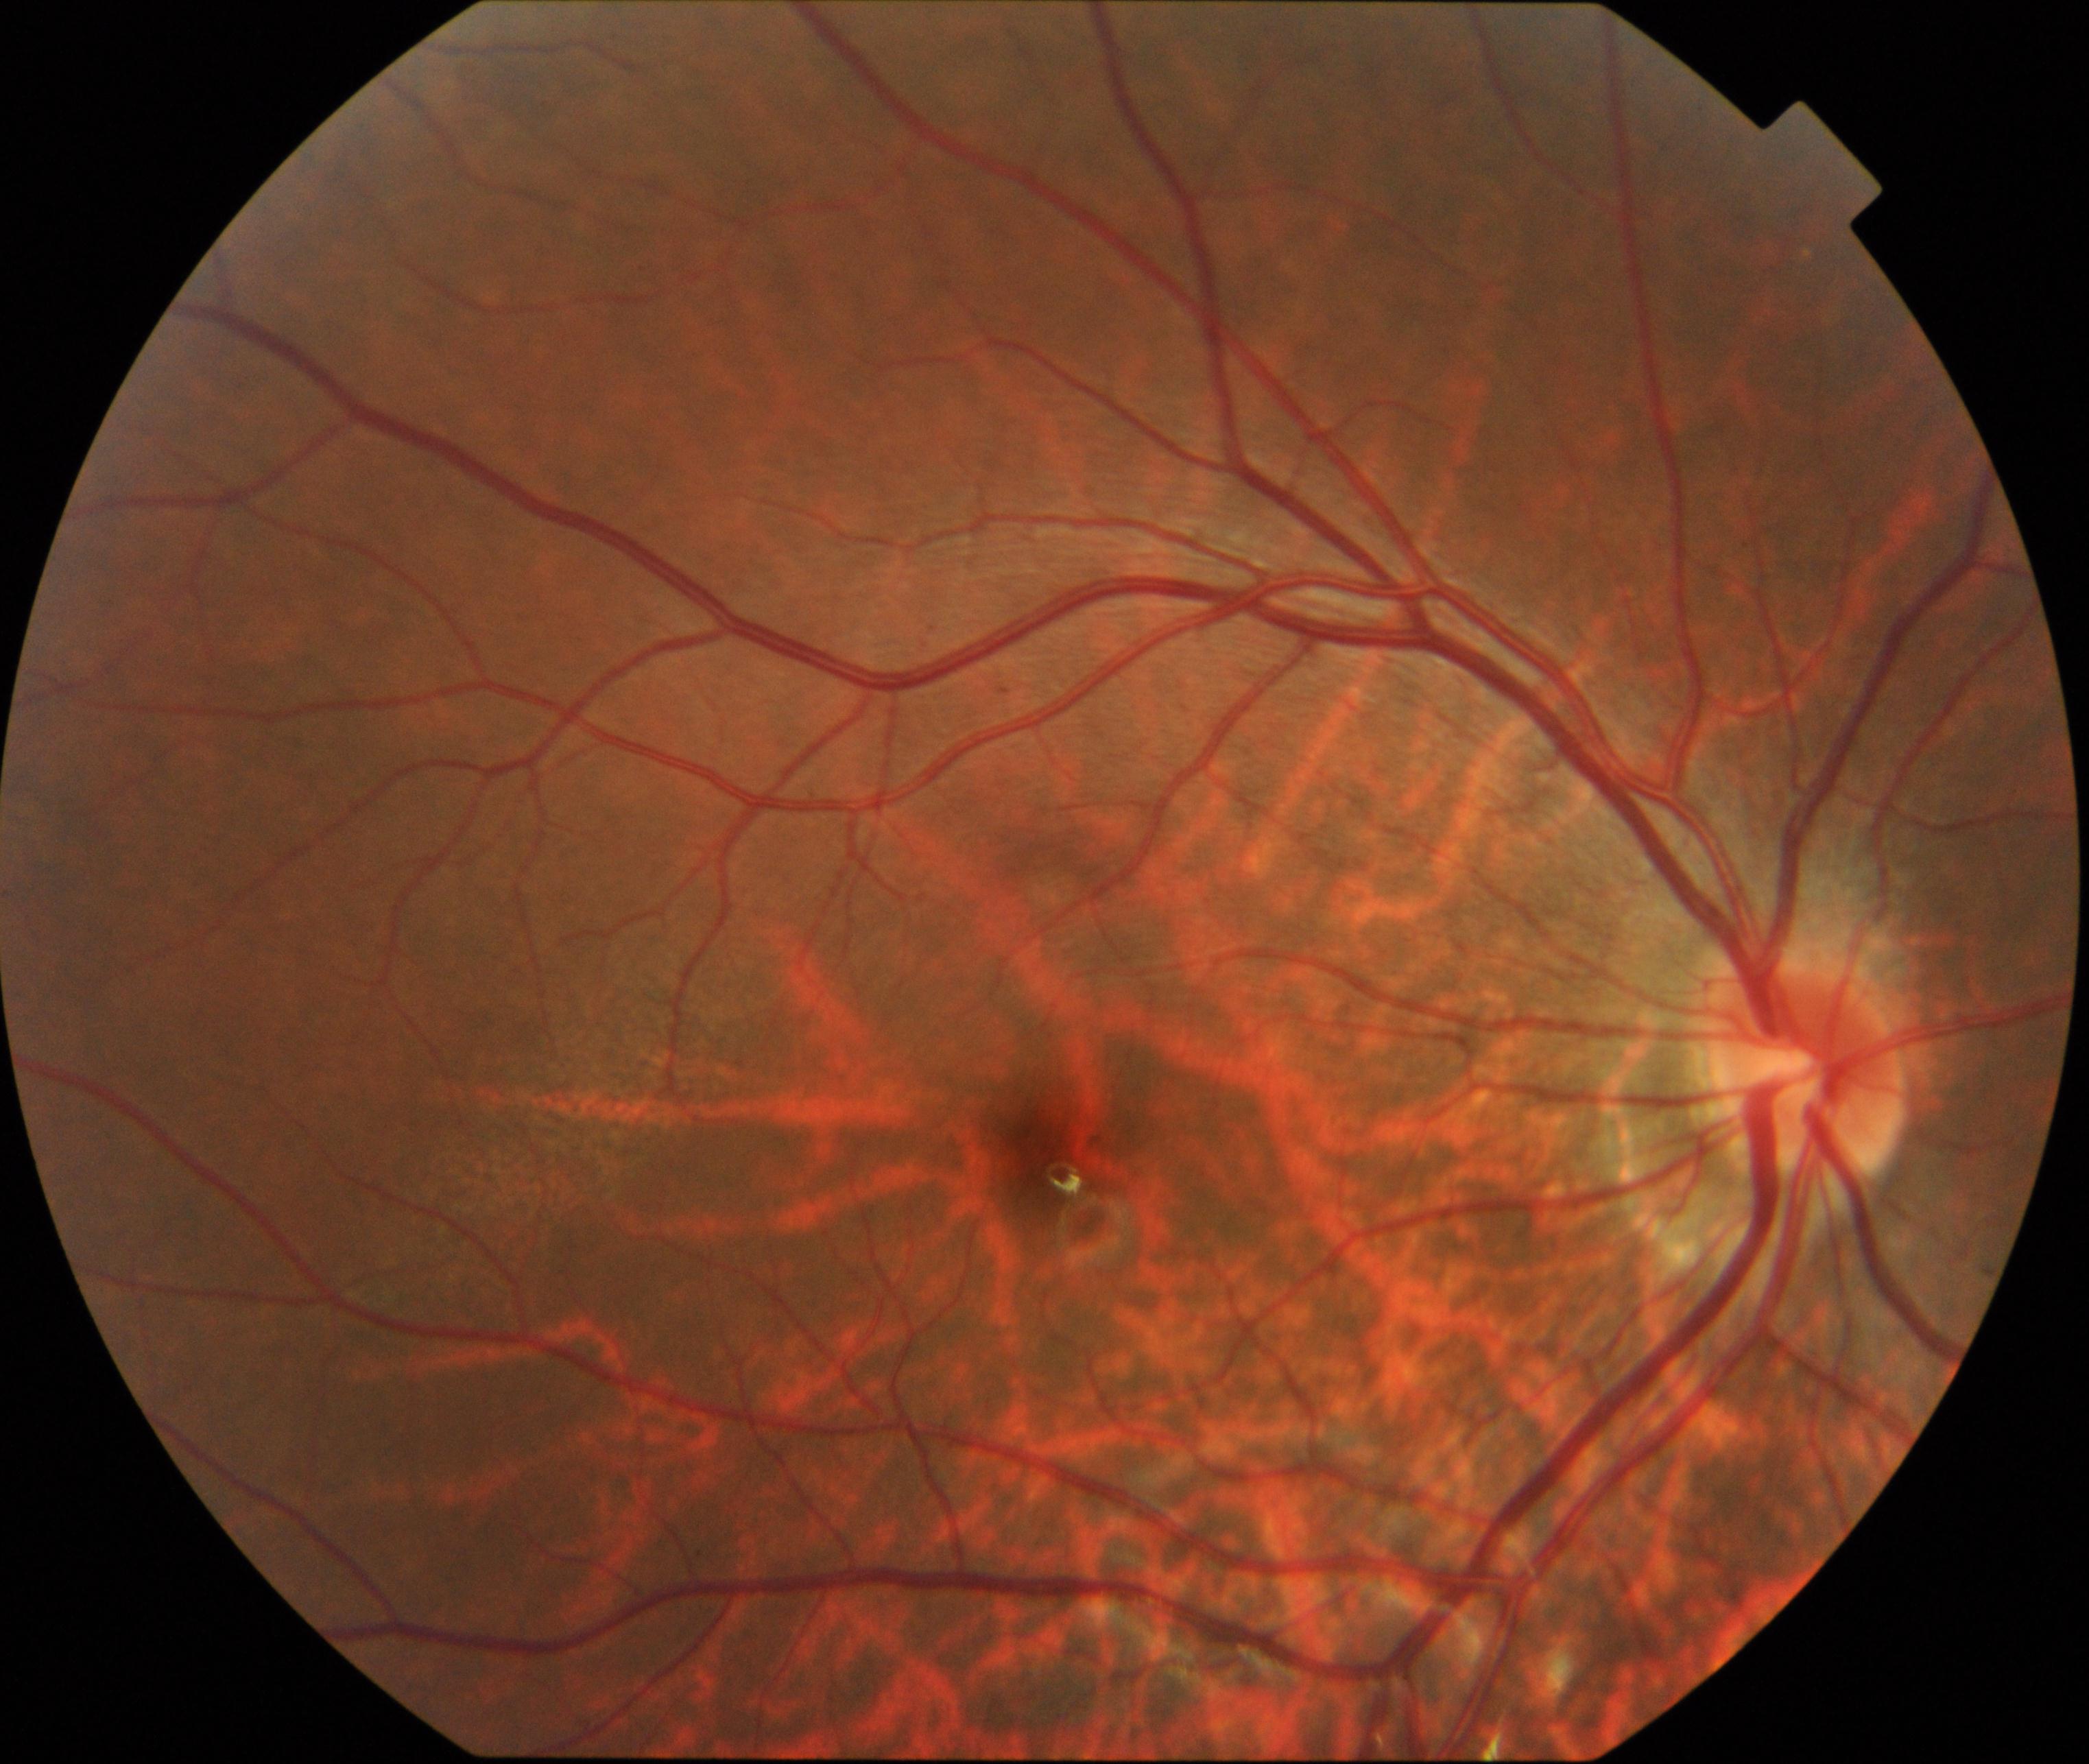
Retinal fundus photograph demonstrating tessellated fundus.